848 by 848 pixels. 45° FOV
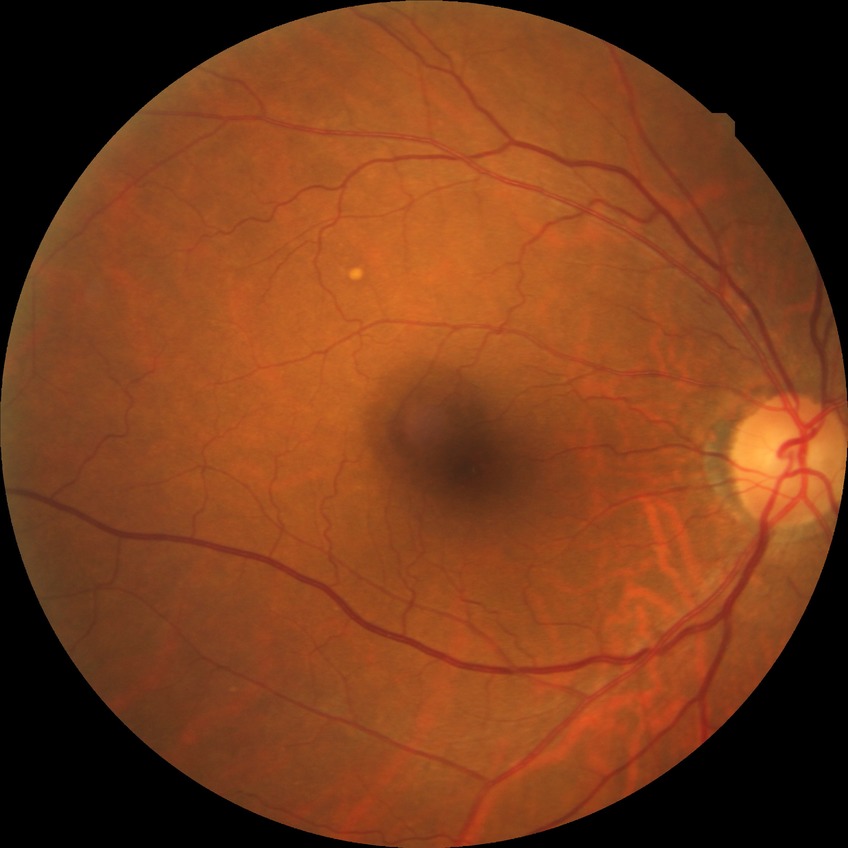 Diabetic retinopathy (DR) is SDR (simple diabetic retinopathy). The retinopathy is classified as non-proliferative diabetic retinopathy.